Fundus photo · 1515x1275.
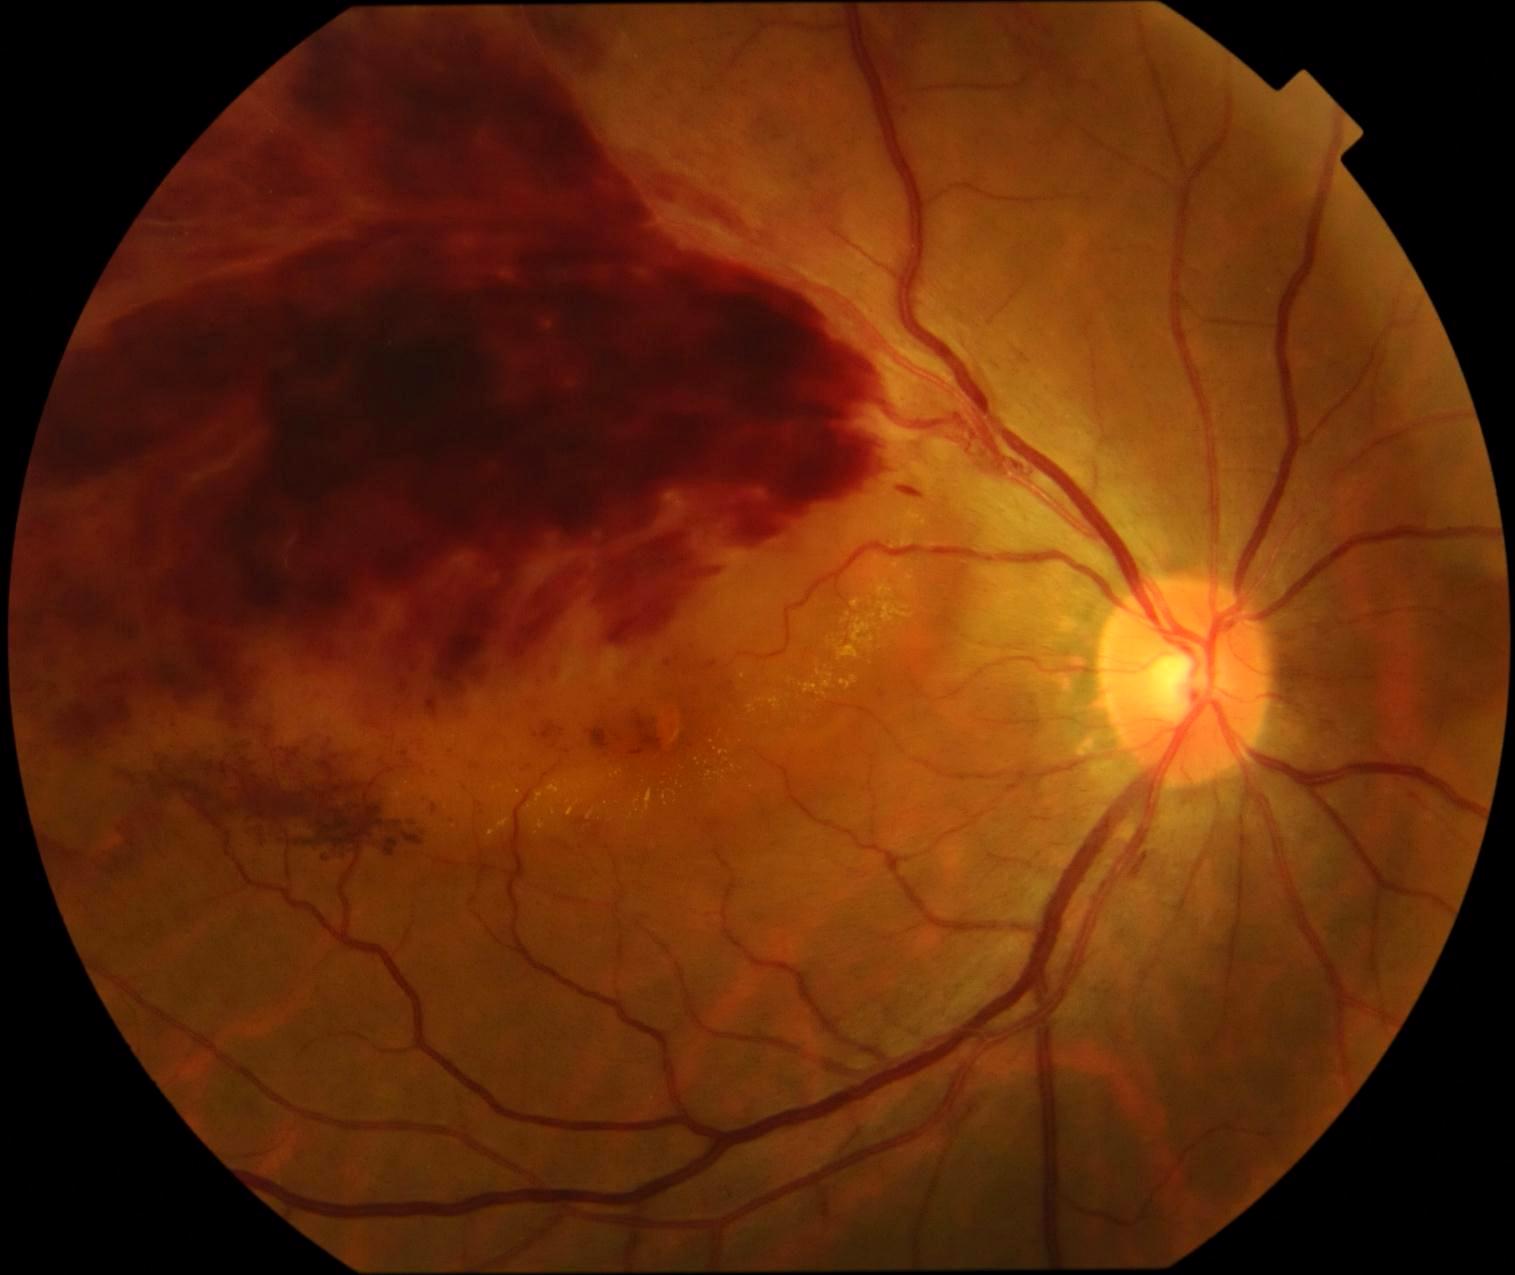 DR severity: grade 4. The retinopathy is classified as proliferative diabetic retinopathy.